Infant wide-field fundus photograph:
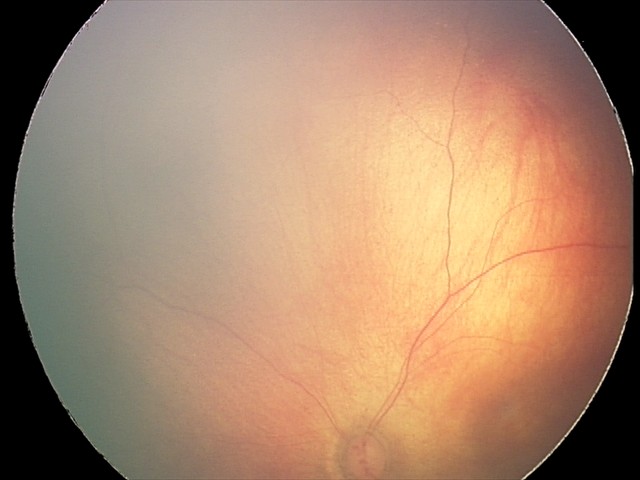
Diagnosis from this screening exam: retinal hemorrhages.